Graded on the modified Davis scale; acquired with a NIDEK AFC-230; 45-degree field of view
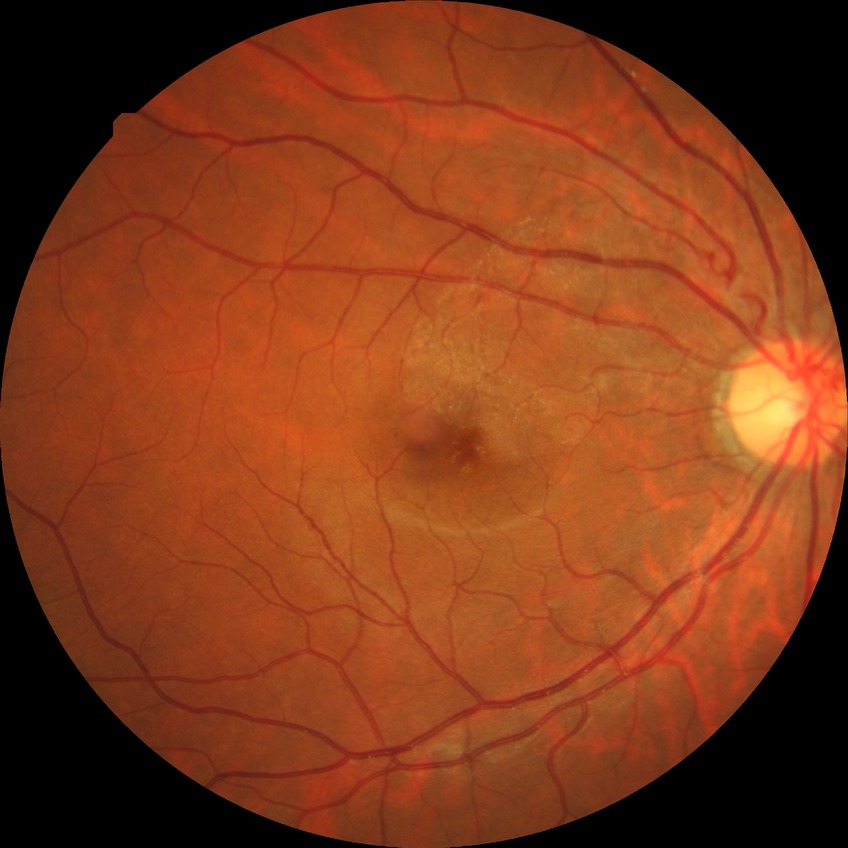

Disease class: non-proliferative diabetic retinopathy. Modified Davis classification: simple diabetic retinopathy.